Wide-field fundus image from infant ROP screening.
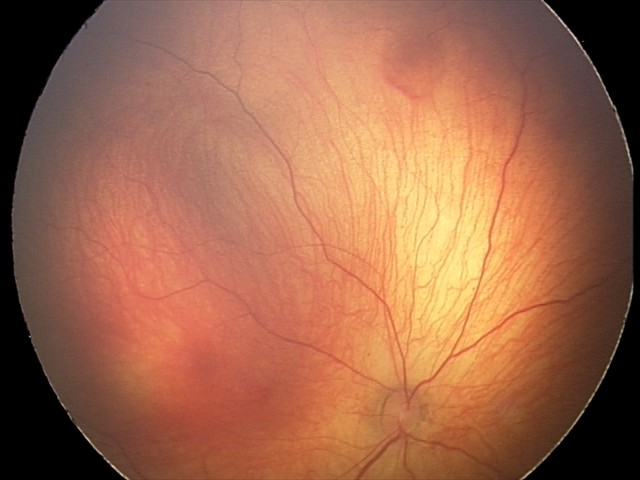 Screening diagnosis: retinal hemorrhages